Retinal fundus photograph, 848 by 848 pixels, Davis DR grading.
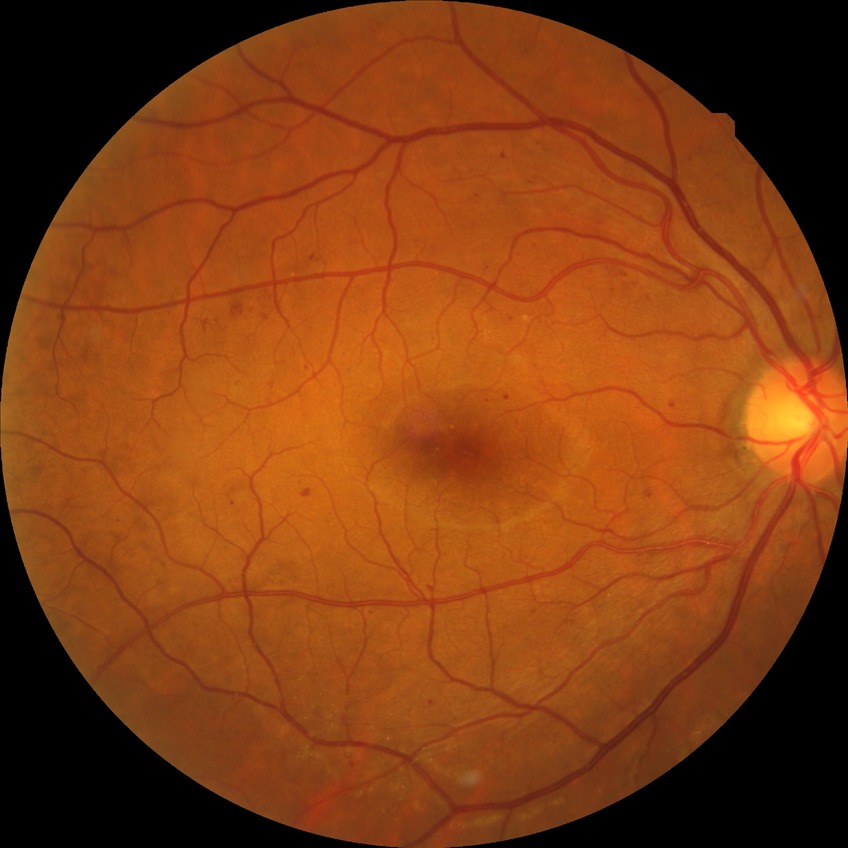 Diabetic retinopathy (DR): SDR (simple diabetic retinopathy). DR class: non-proliferative diabetic retinopathy.